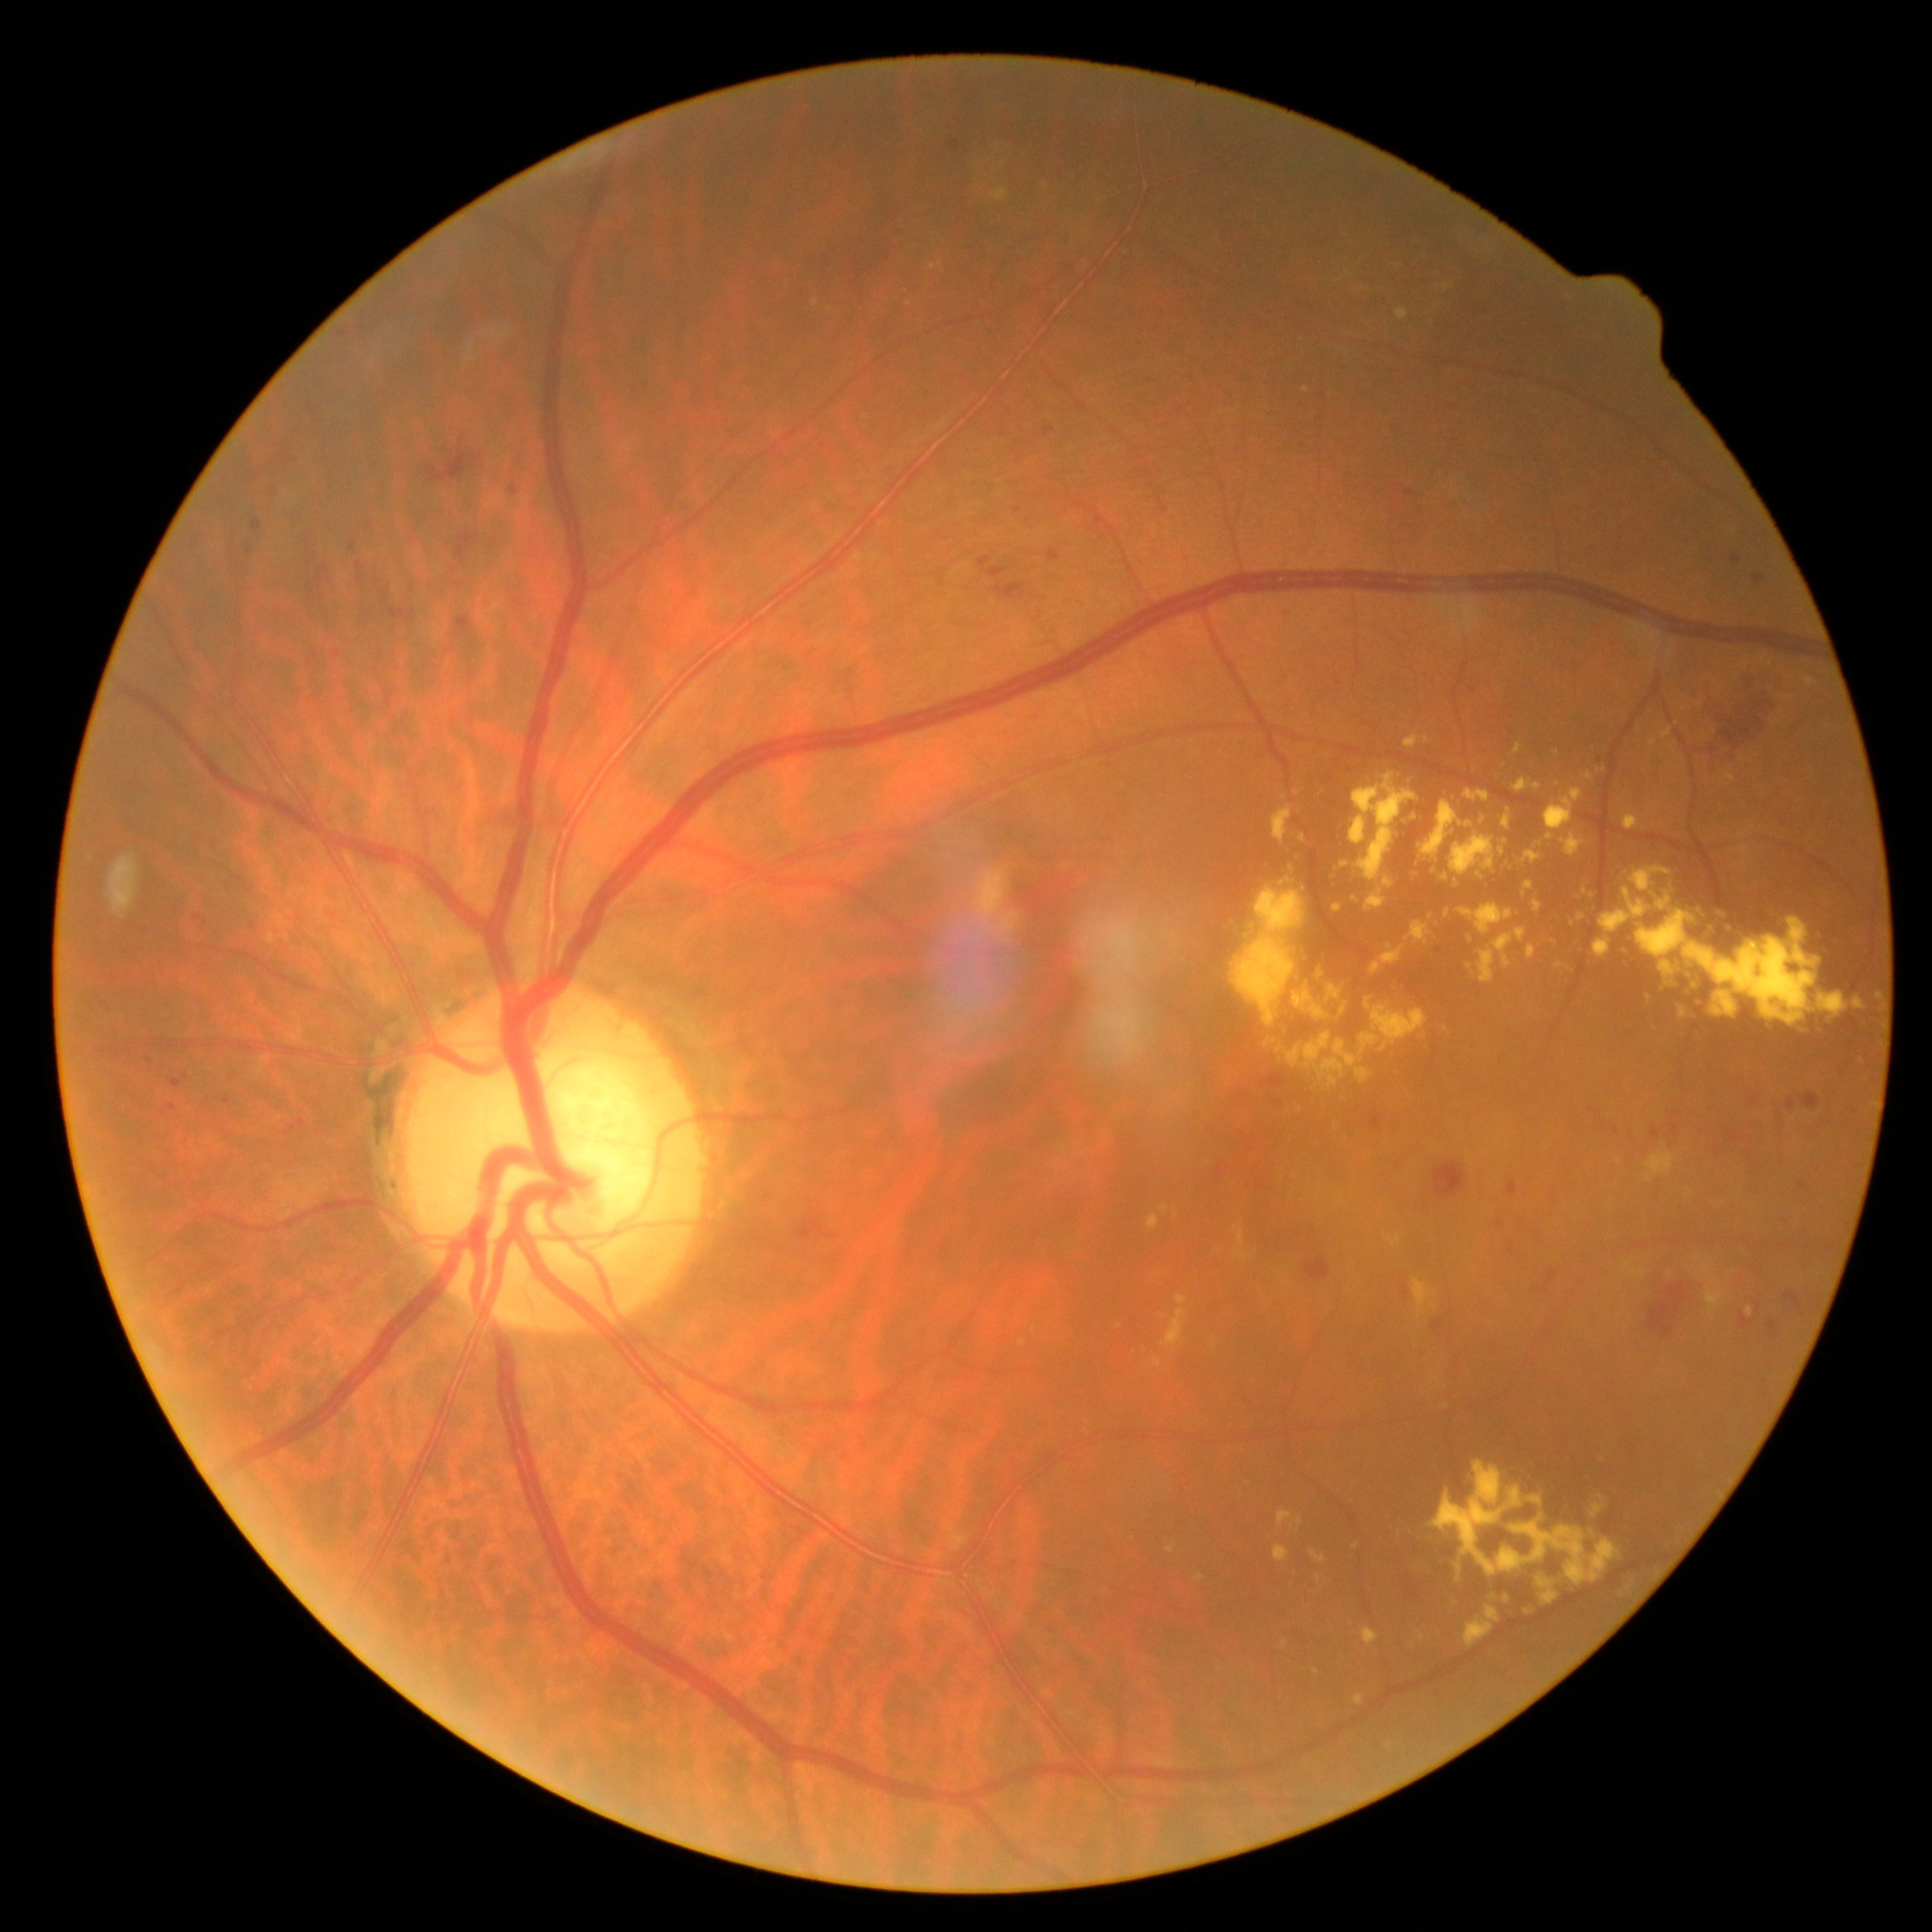 {"partial":true,"dr_grade":2,"dr_grade_name":"moderate NPDR","lesions":{"he":[[1280,609,1293,618],[453,531,479,565],[1022,374,1038,385],[1262,1074,1285,1088],[147,1056,153,1064],[1807,1156,1822,1176],[383,586,391,595],[221,1096,232,1105],[247,545,253,556],[358,1508,373,1522],[1719,1262,1787,1341],[512,488,518,497],[1751,574,1764,586]],"he_small_centers":[[449,1560],[1730,1131],[1298,1234],[454,570]],"ex":[[1159,1206,1168,1213],[1666,743,1675,749],[1413,1277,1432,1315],[1167,1545,1176,1554],[992,190,1010,202],[1395,308,1409,320],[1237,1251,1247,1259],[1386,1236,1400,1245],[1707,1286,1722,1306],[1406,738,1640,889]],"ex_small_centers":[[910,303],[1300,1110],[829,311],[1861,1062],[1318,1197],[1696,1257],[1435,1309]]}}